Pediatric retinal photograph (wide-field)
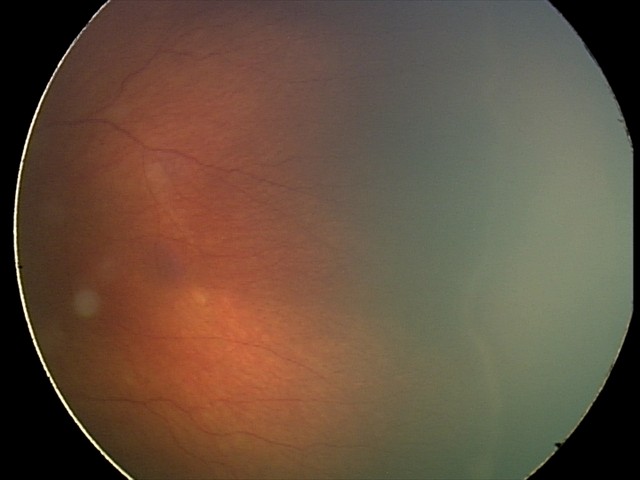
Without plus disease.
Examination diagnosed as retinopathy of prematurity (ROP) stage 2.